45° FOV: 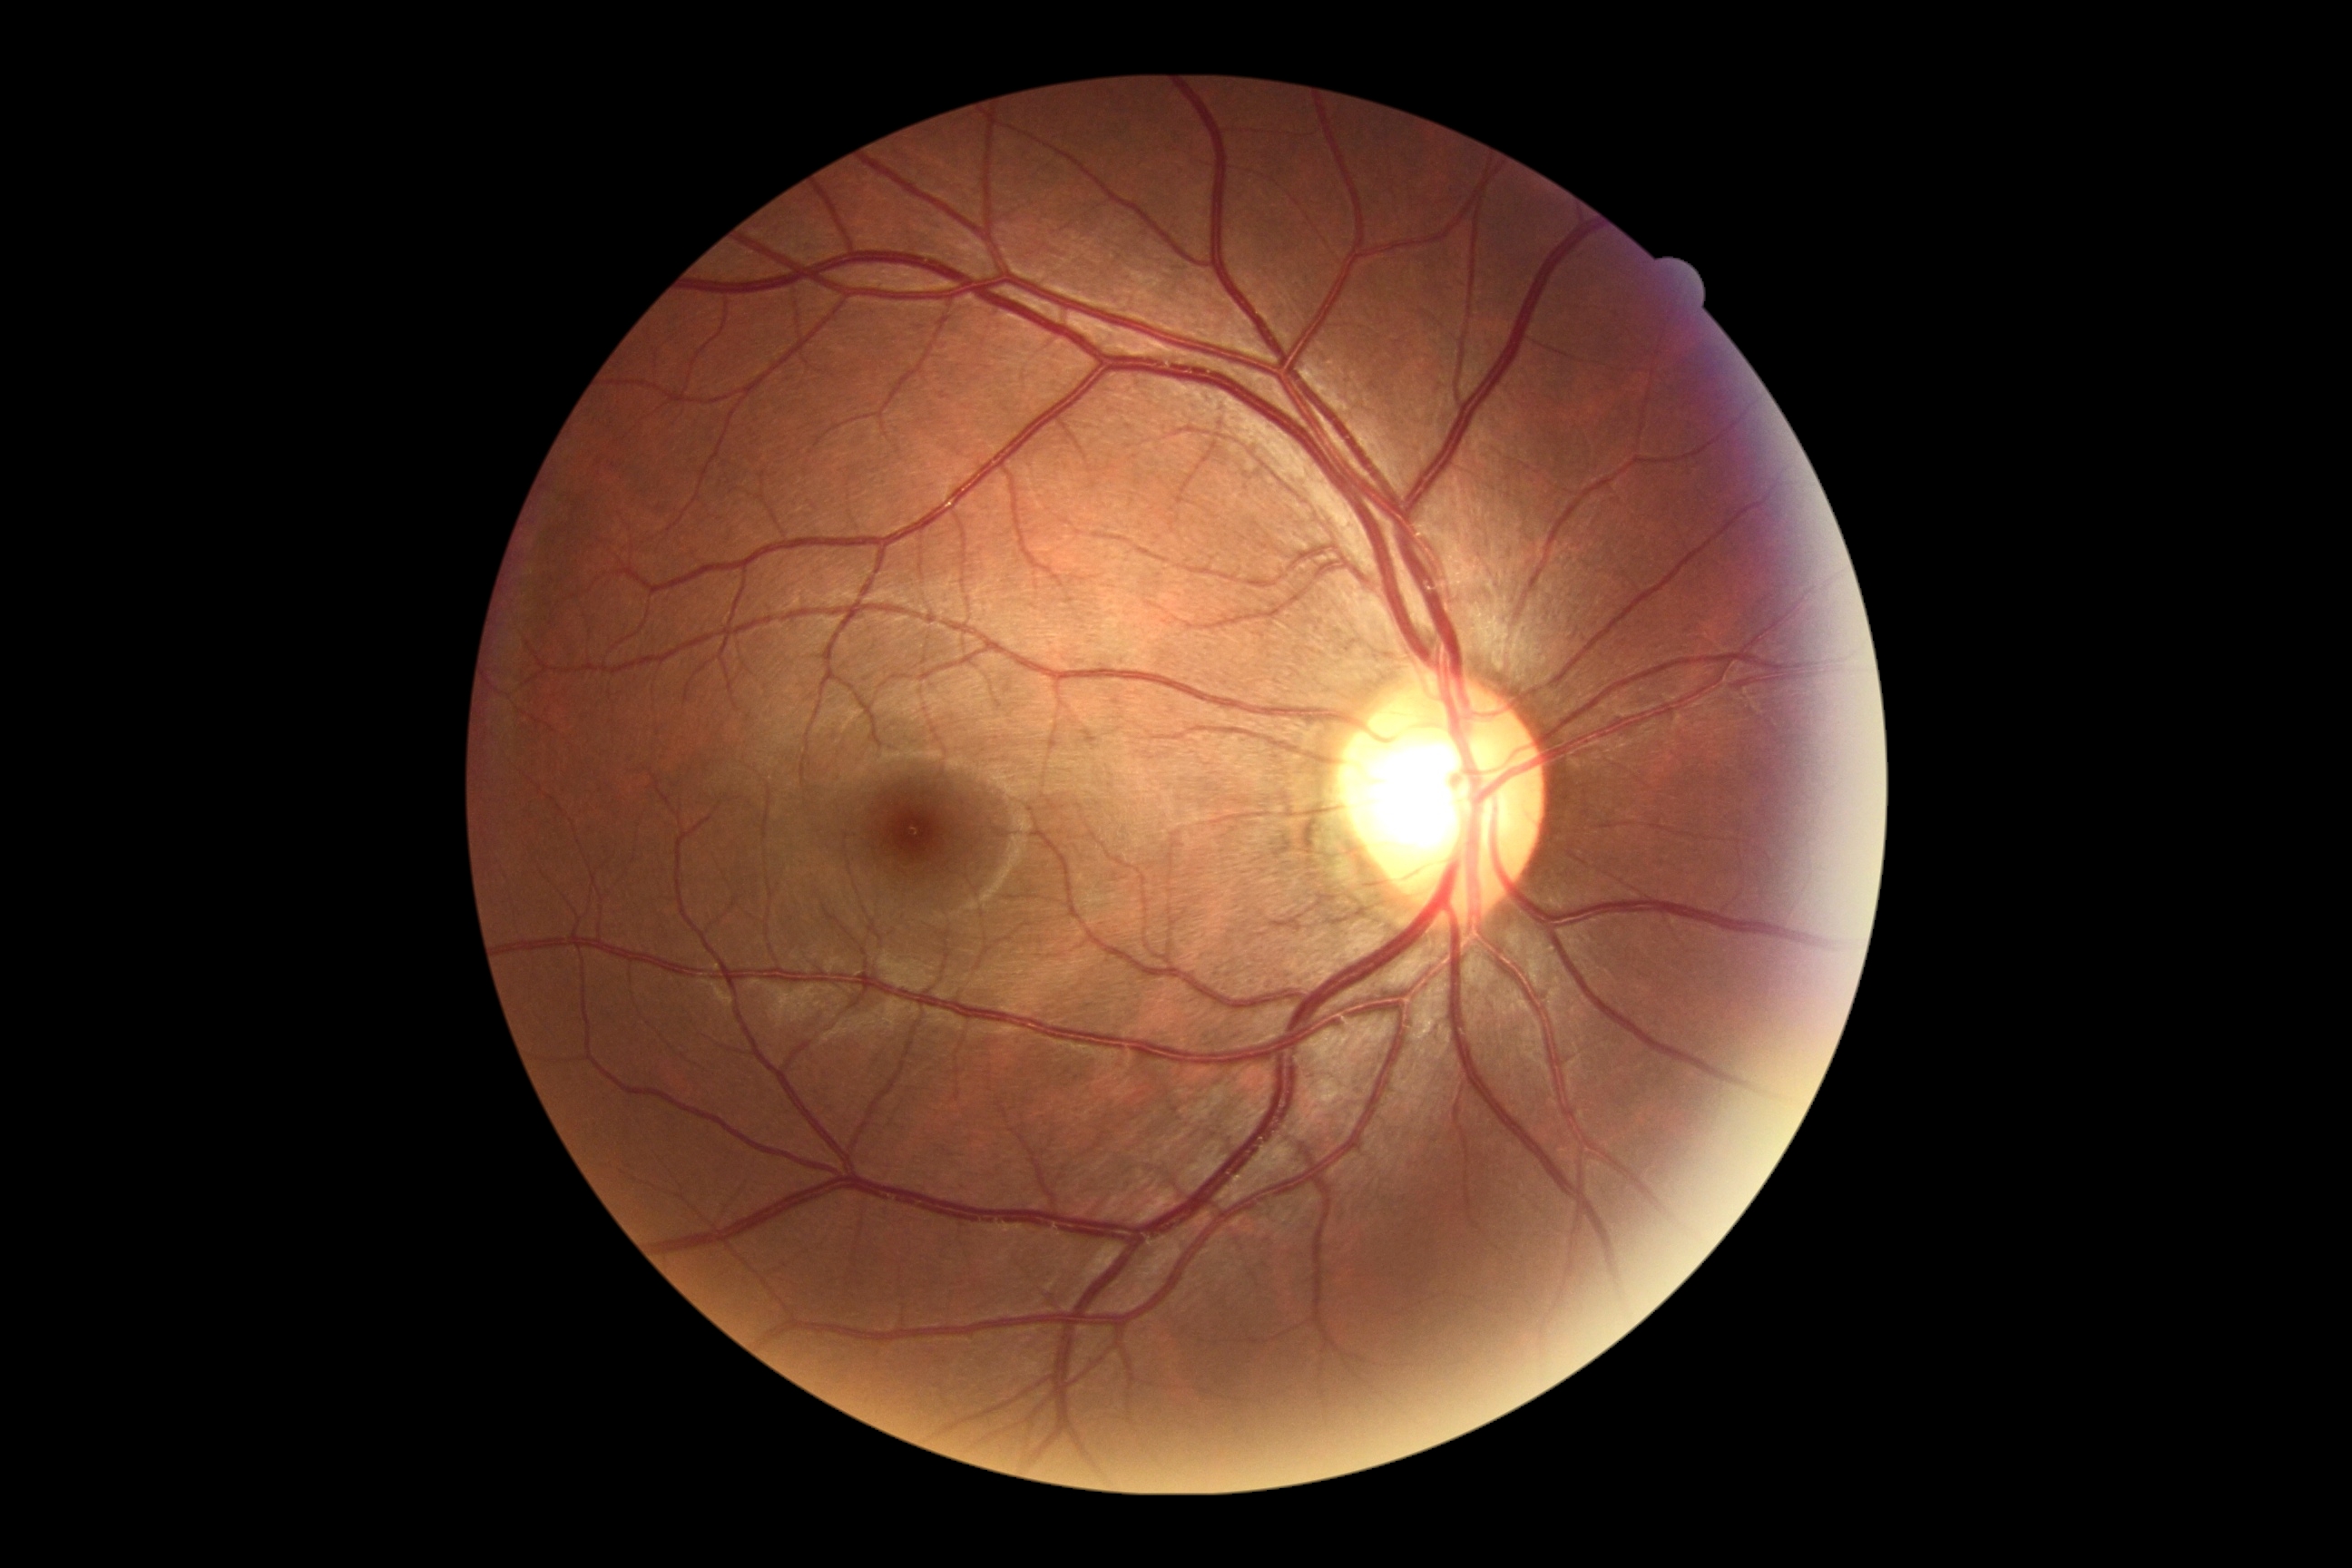

No apparent diabetic retinopathy.
Diabetic retinopathy: no apparent retinopathy (grade 0).